Central posterior field; mydriatic (tropicamide and phenylephrine); color fundus photograph — 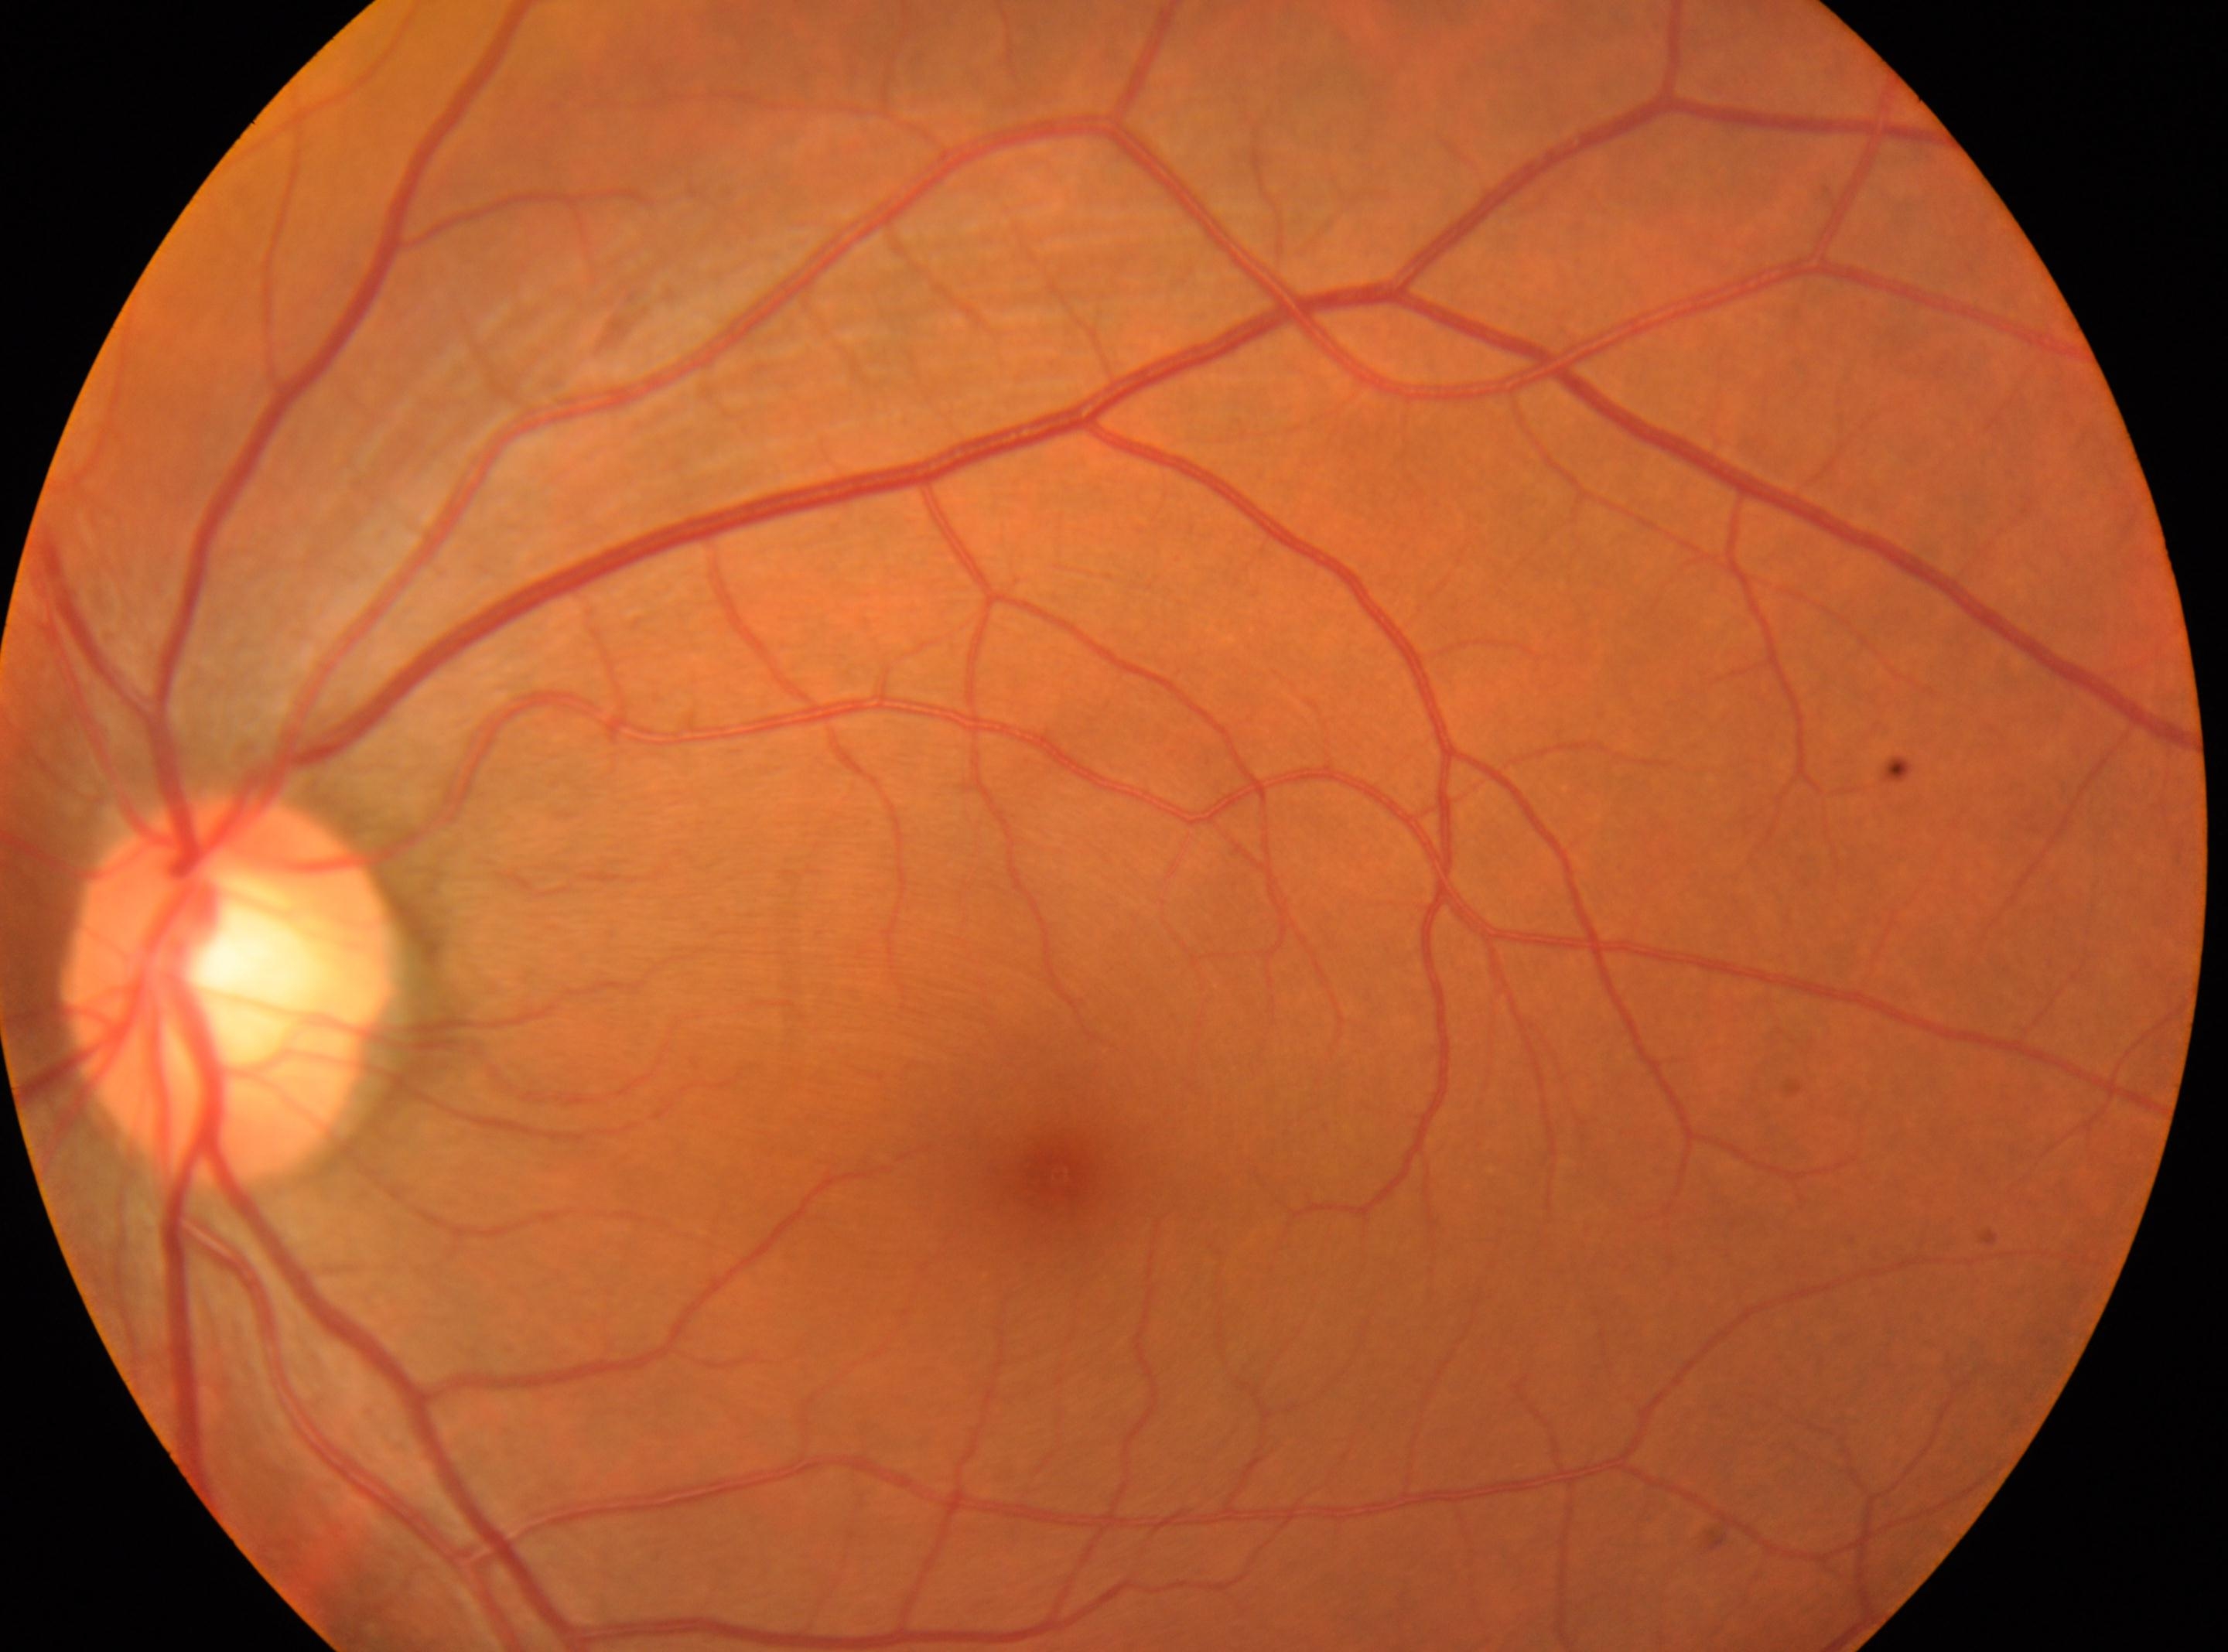
Eye: left. DR: 0/4. Fovea: 1058px, 1172px. Optic disk located at 232px, 988px.